Fundus photo. Camera: NIDEK AFC-230. DR severity per modified Davis staging. 848x848px. FOV: 45 degrees.
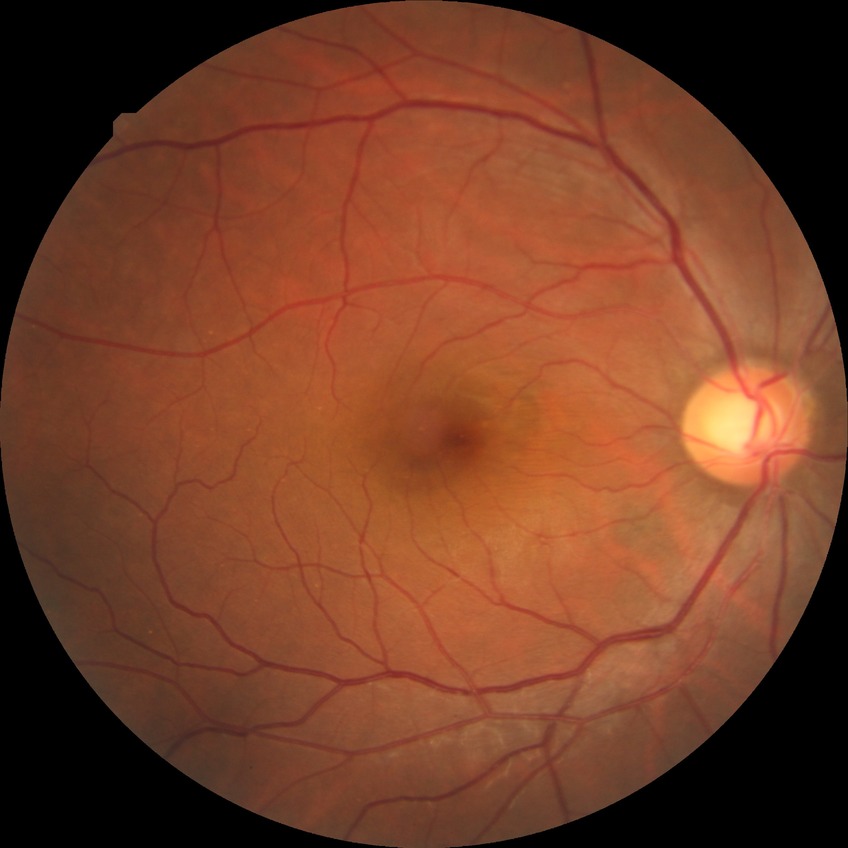 Modified Davis grading: no diabetic retinopathy.